45-degree field of view · 2352 by 1568 pixels — 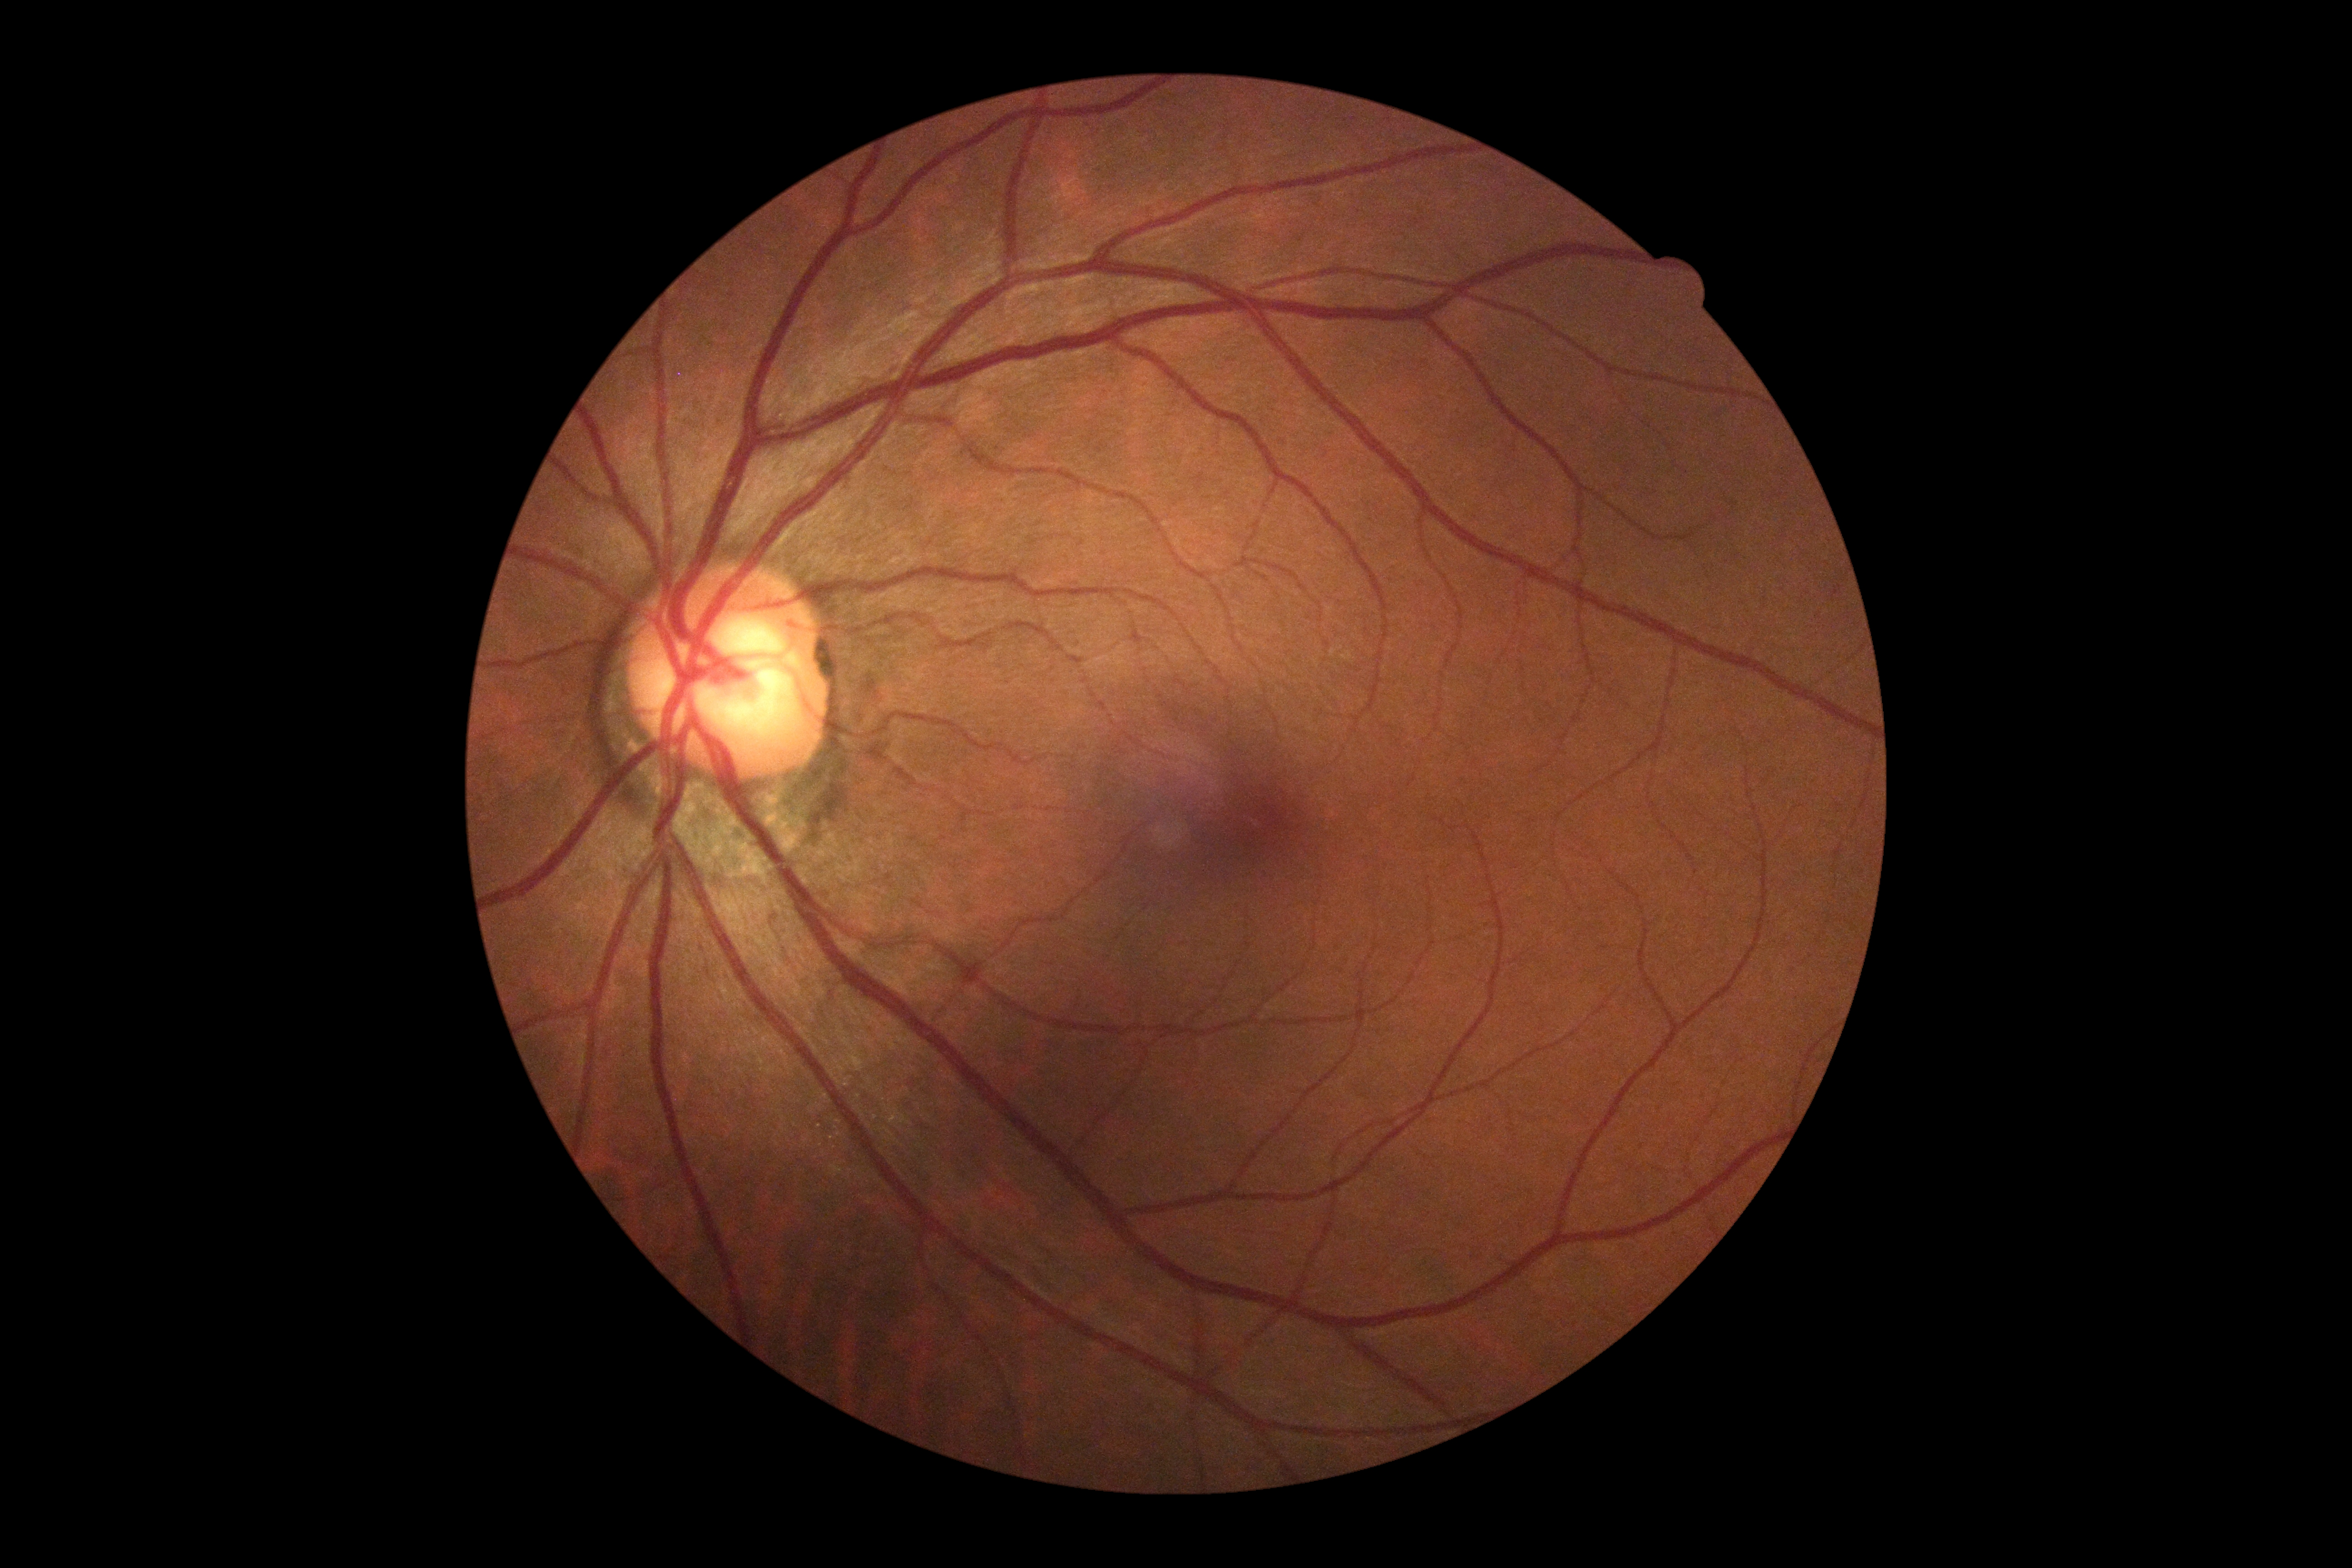 DR stage is no apparent retinopathy (grade 0).